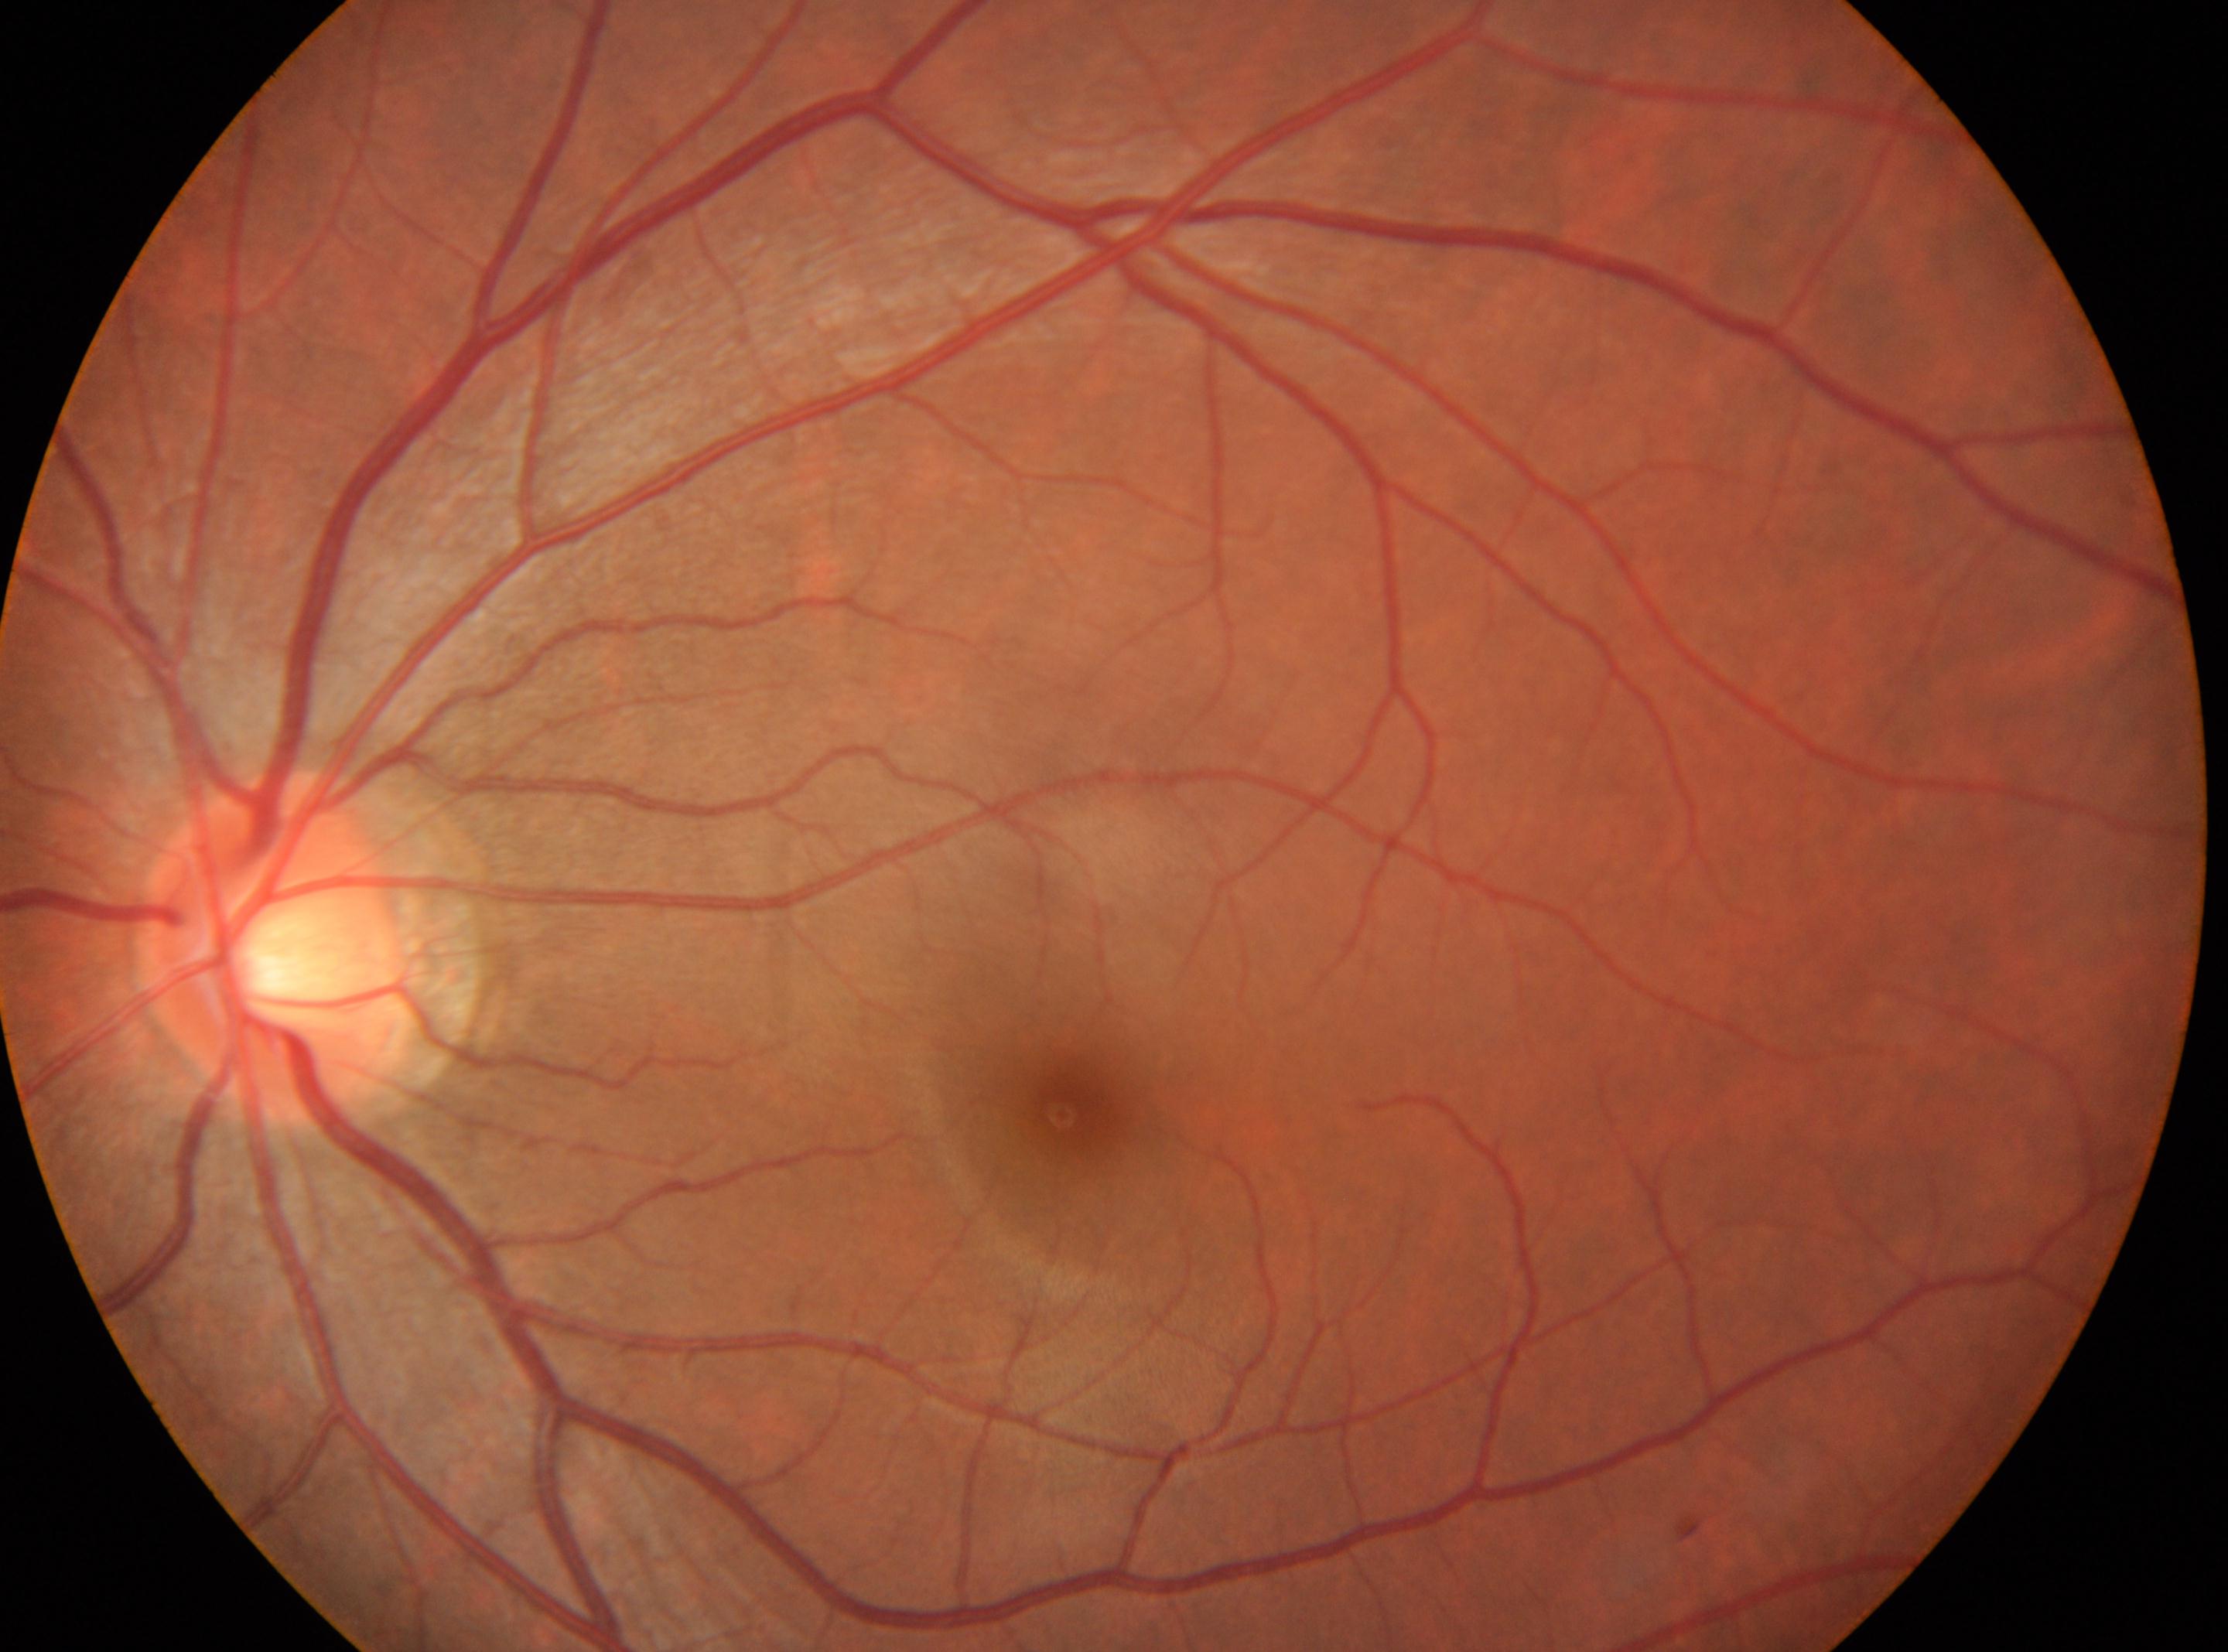 disc center: (278,947); macular center: (1072,1103); DR impression: No diabetic retinal disease findings; laterality: left; DR grade: 0.